2352x1568px.
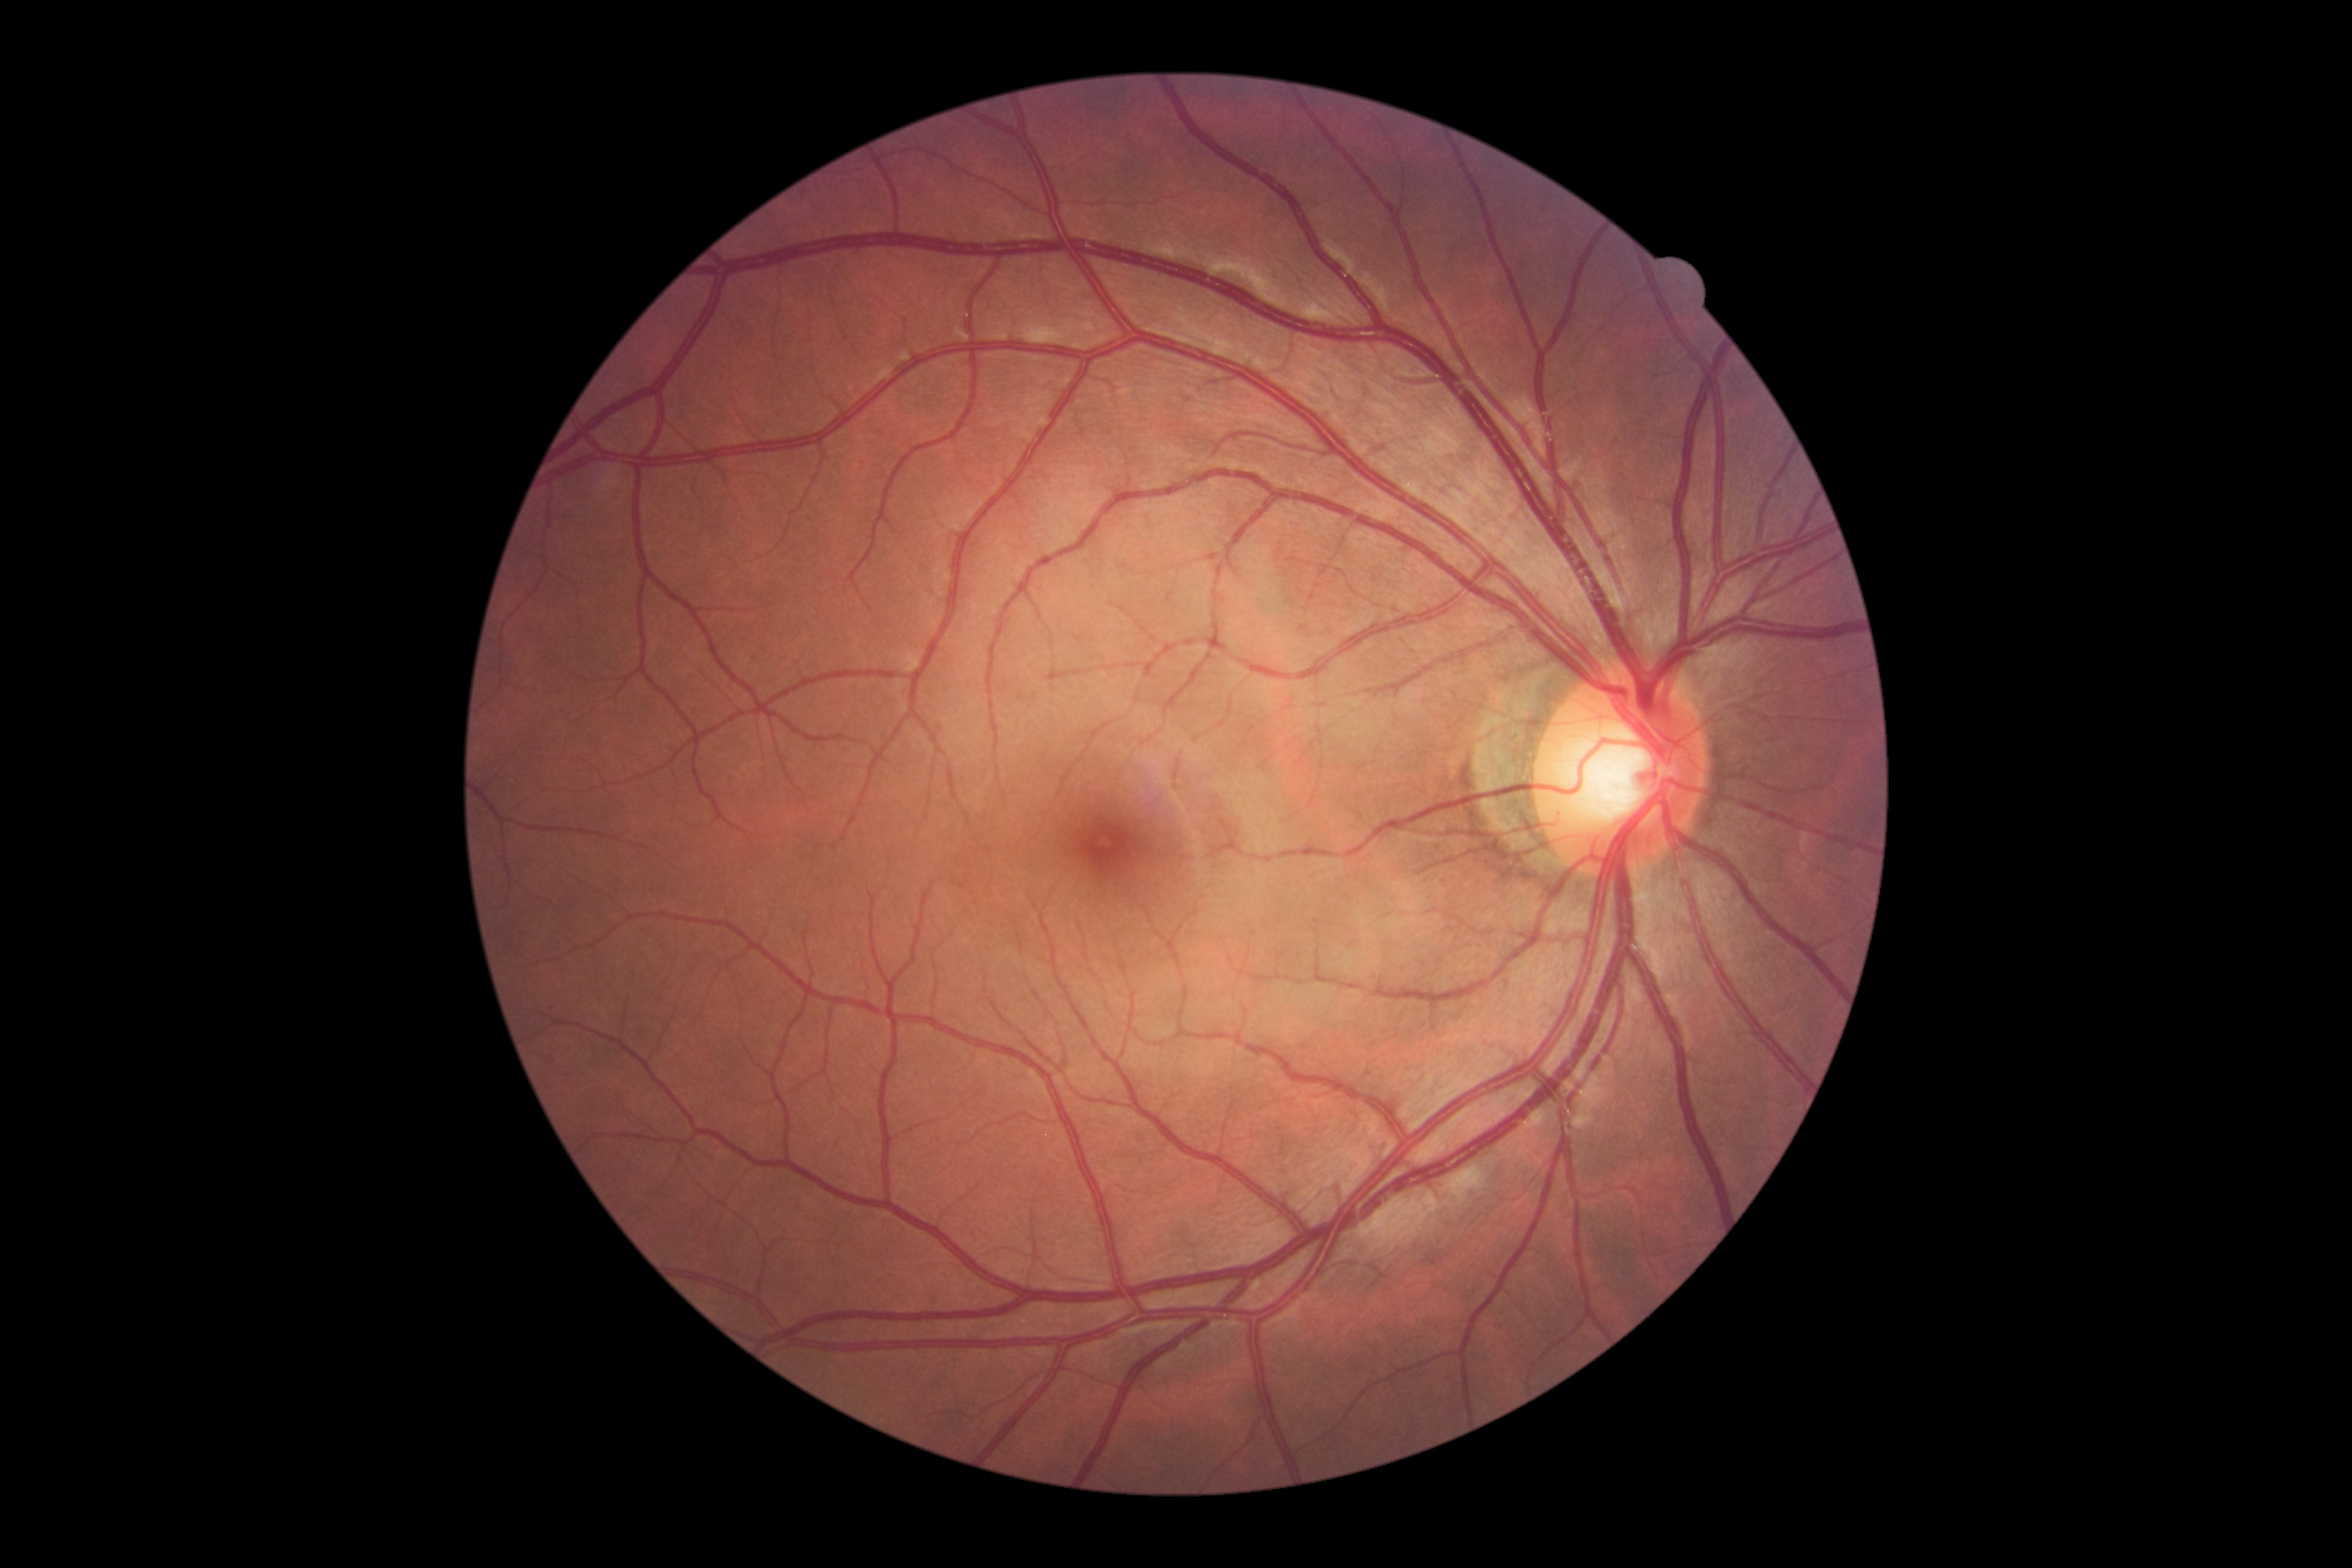 Annotations:
• DR impression: no apparent DR
• retinopathy: grade 0